1240x1240 · pediatric wide-field fundus photograph:
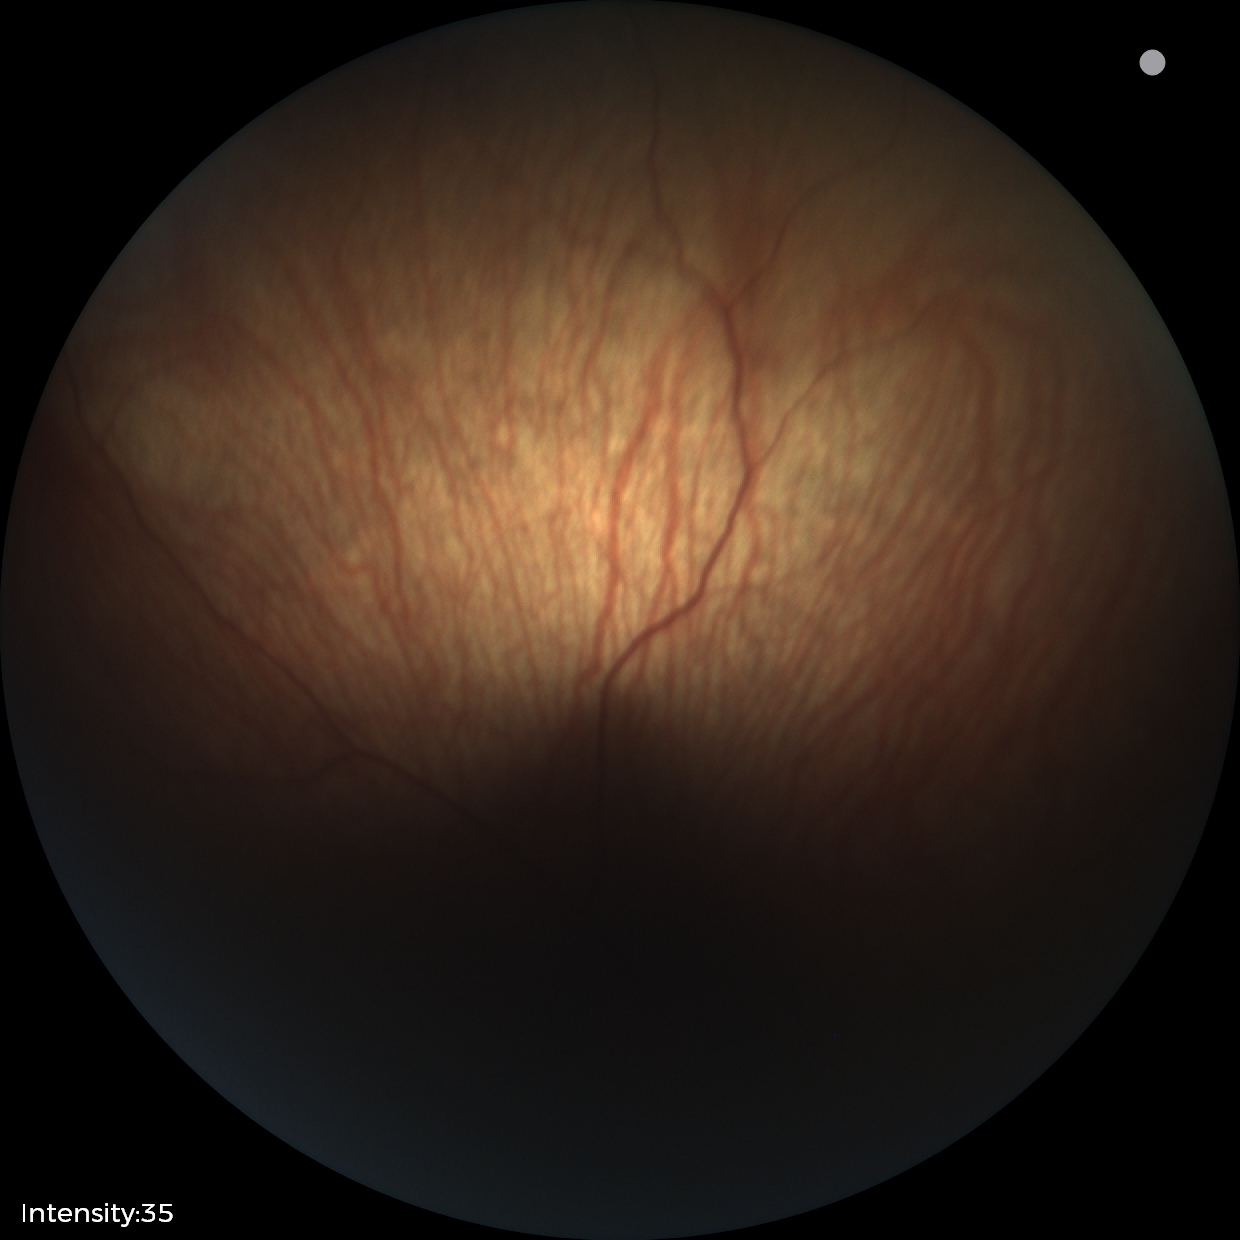 Examination with physiological retinal findings.